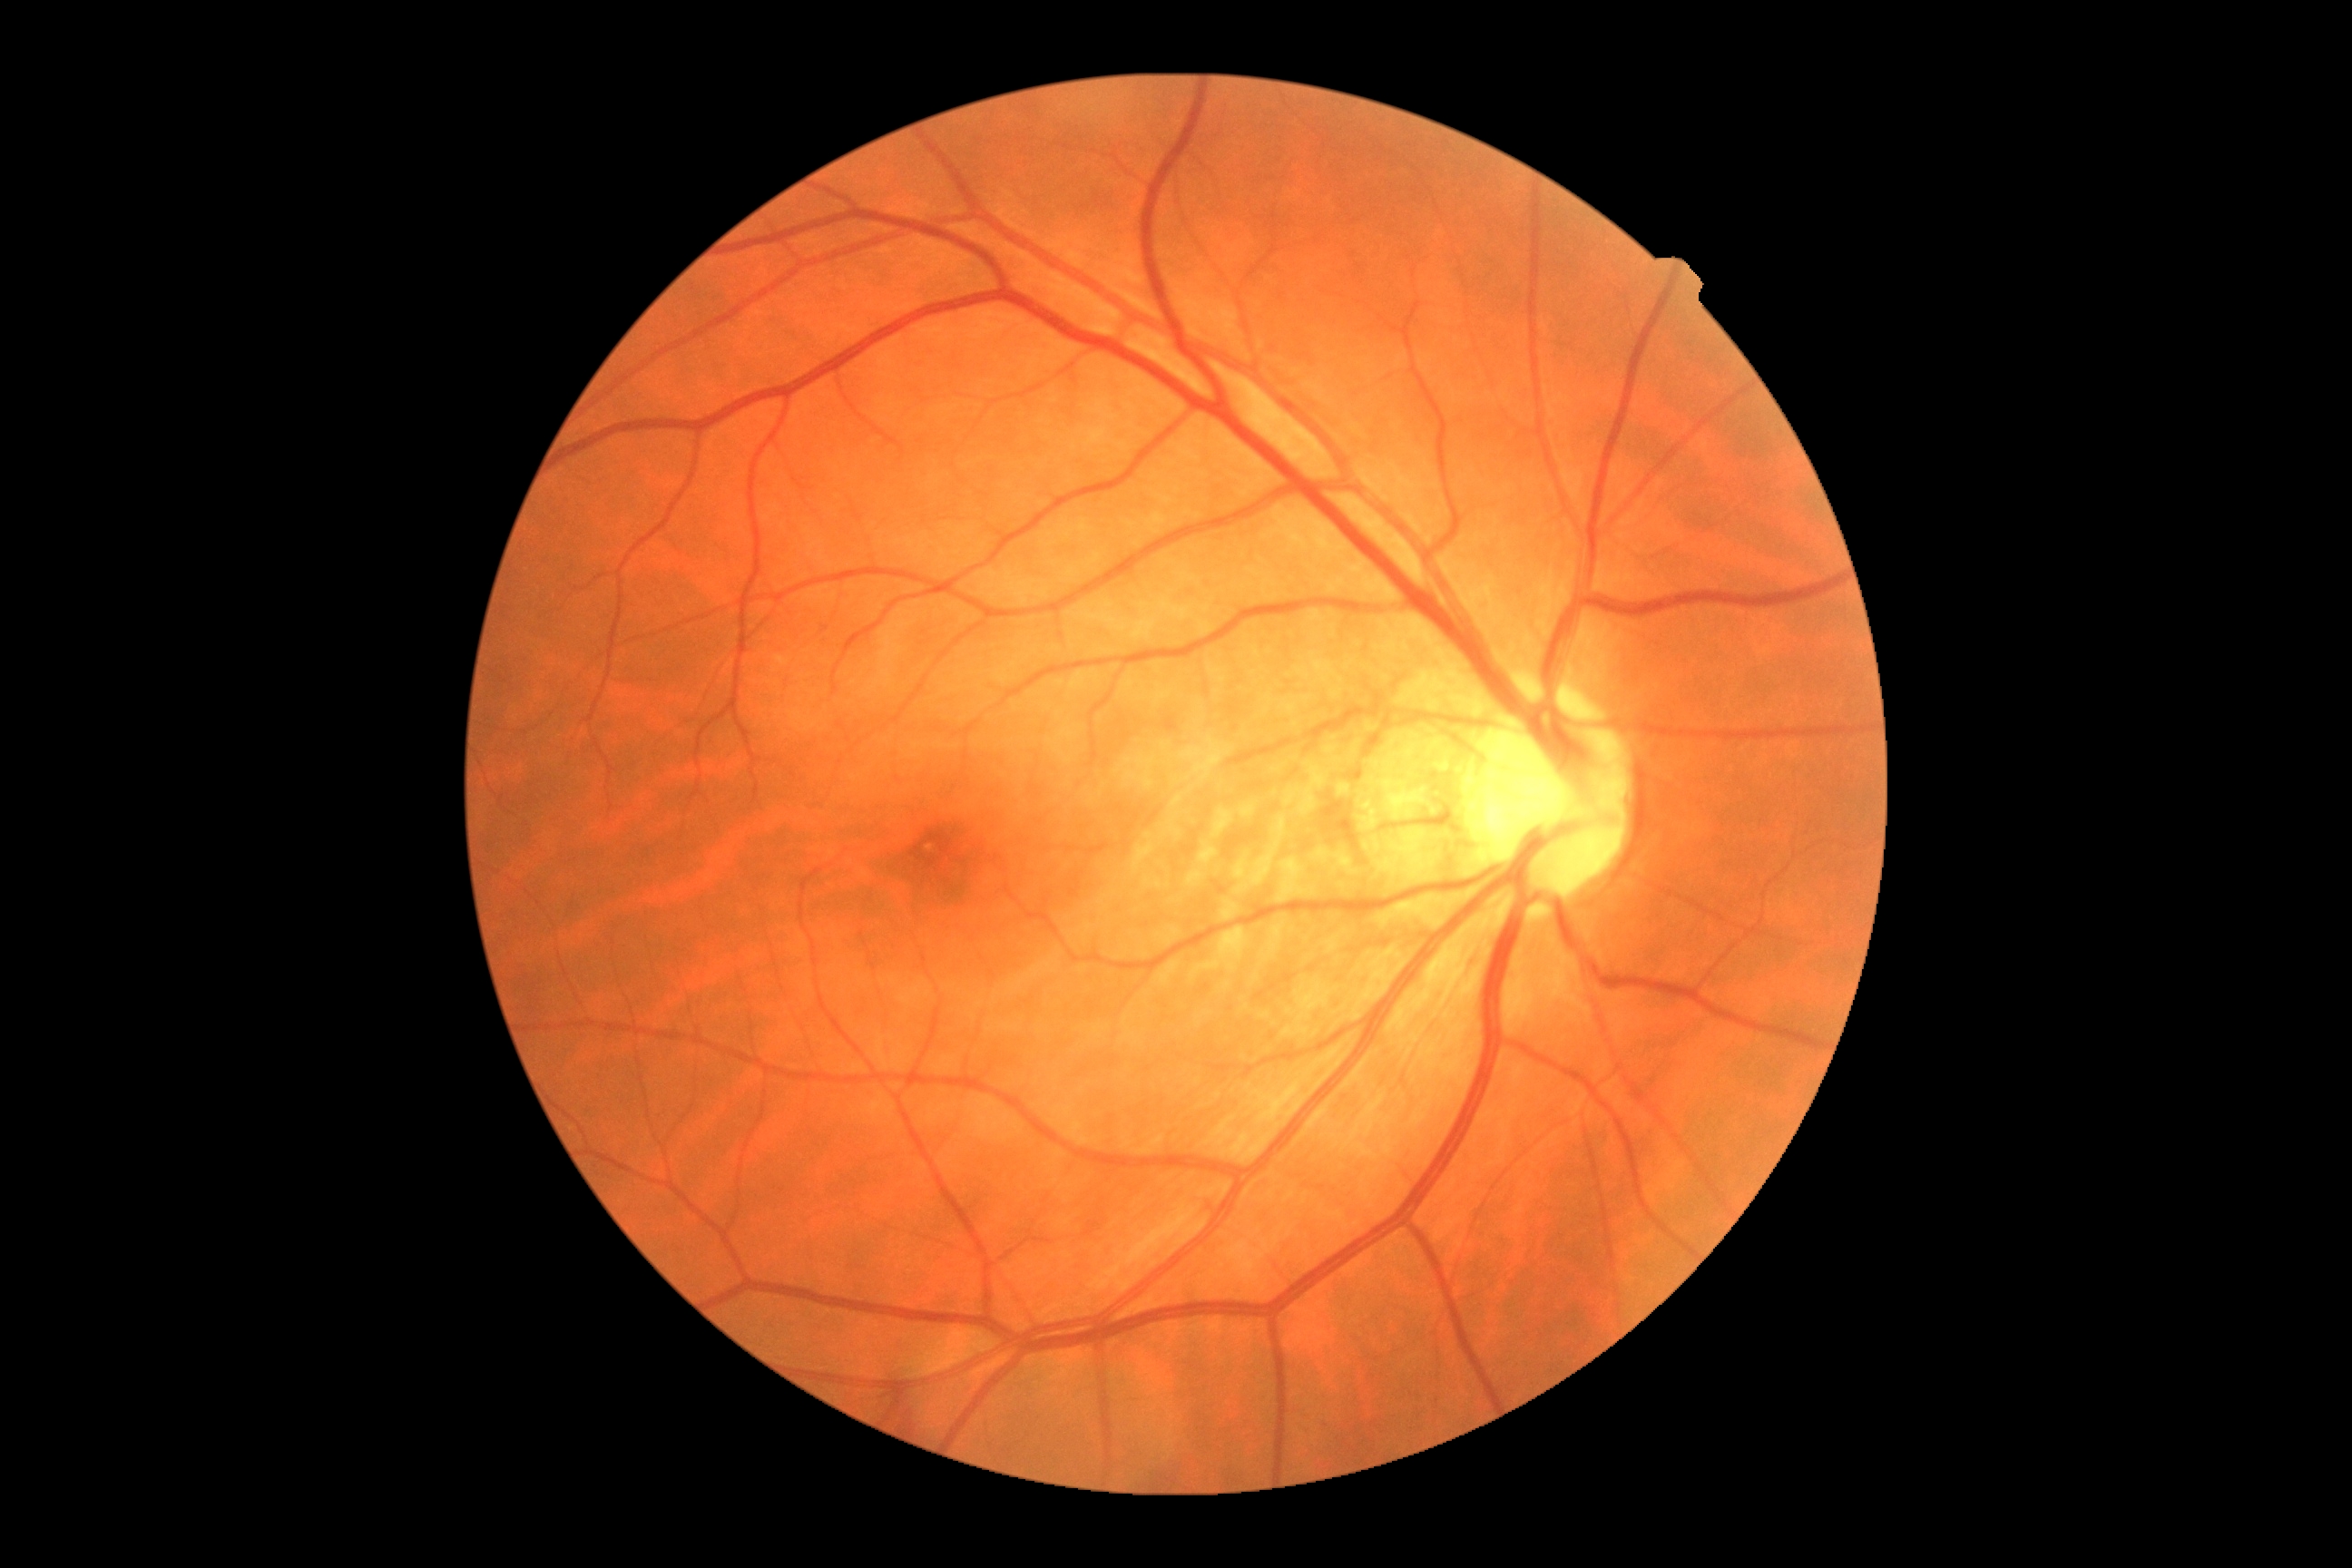
DR: 0.